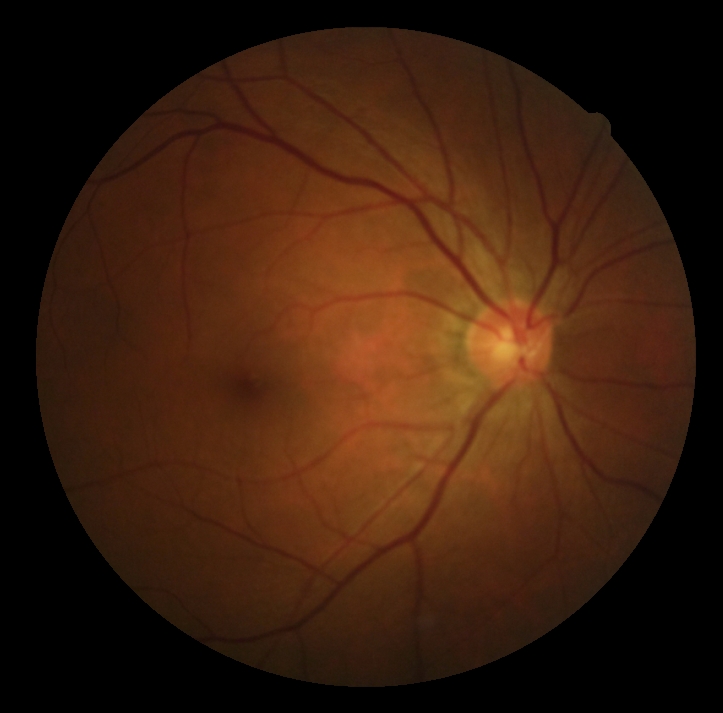
DR severity is no apparent retinopathy (grade 0).